45-degree field of view:
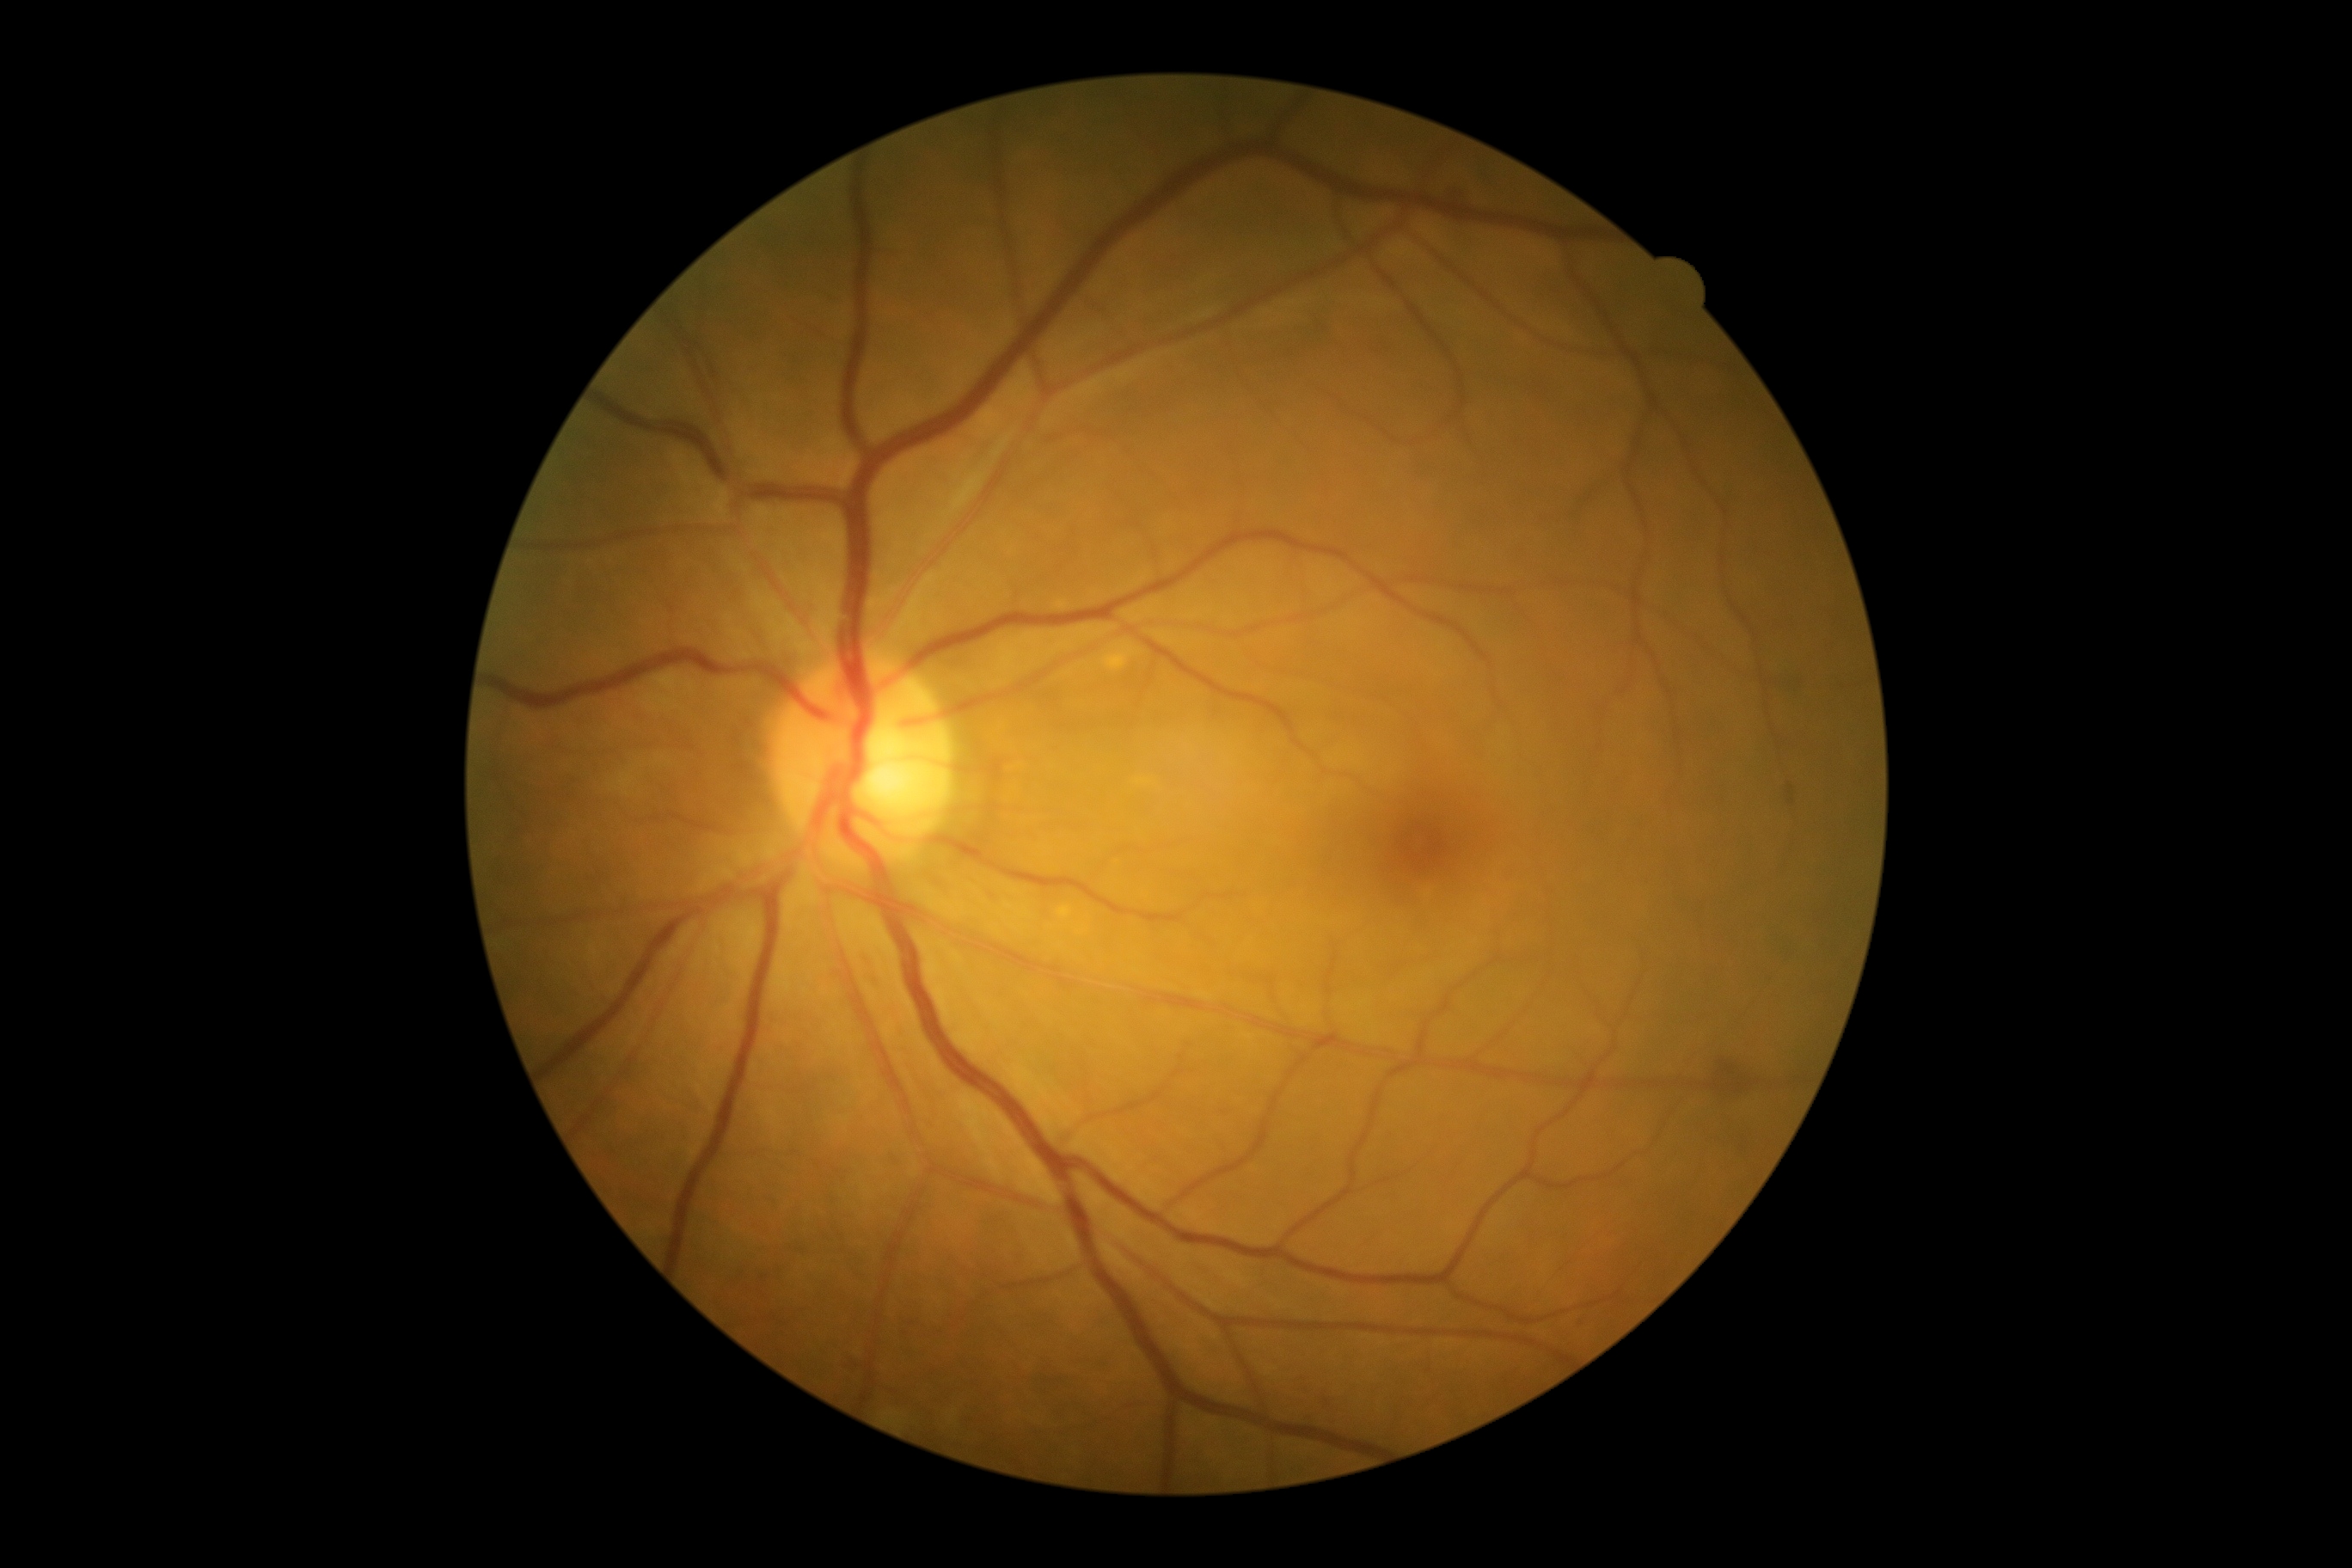

DR grade: 2.